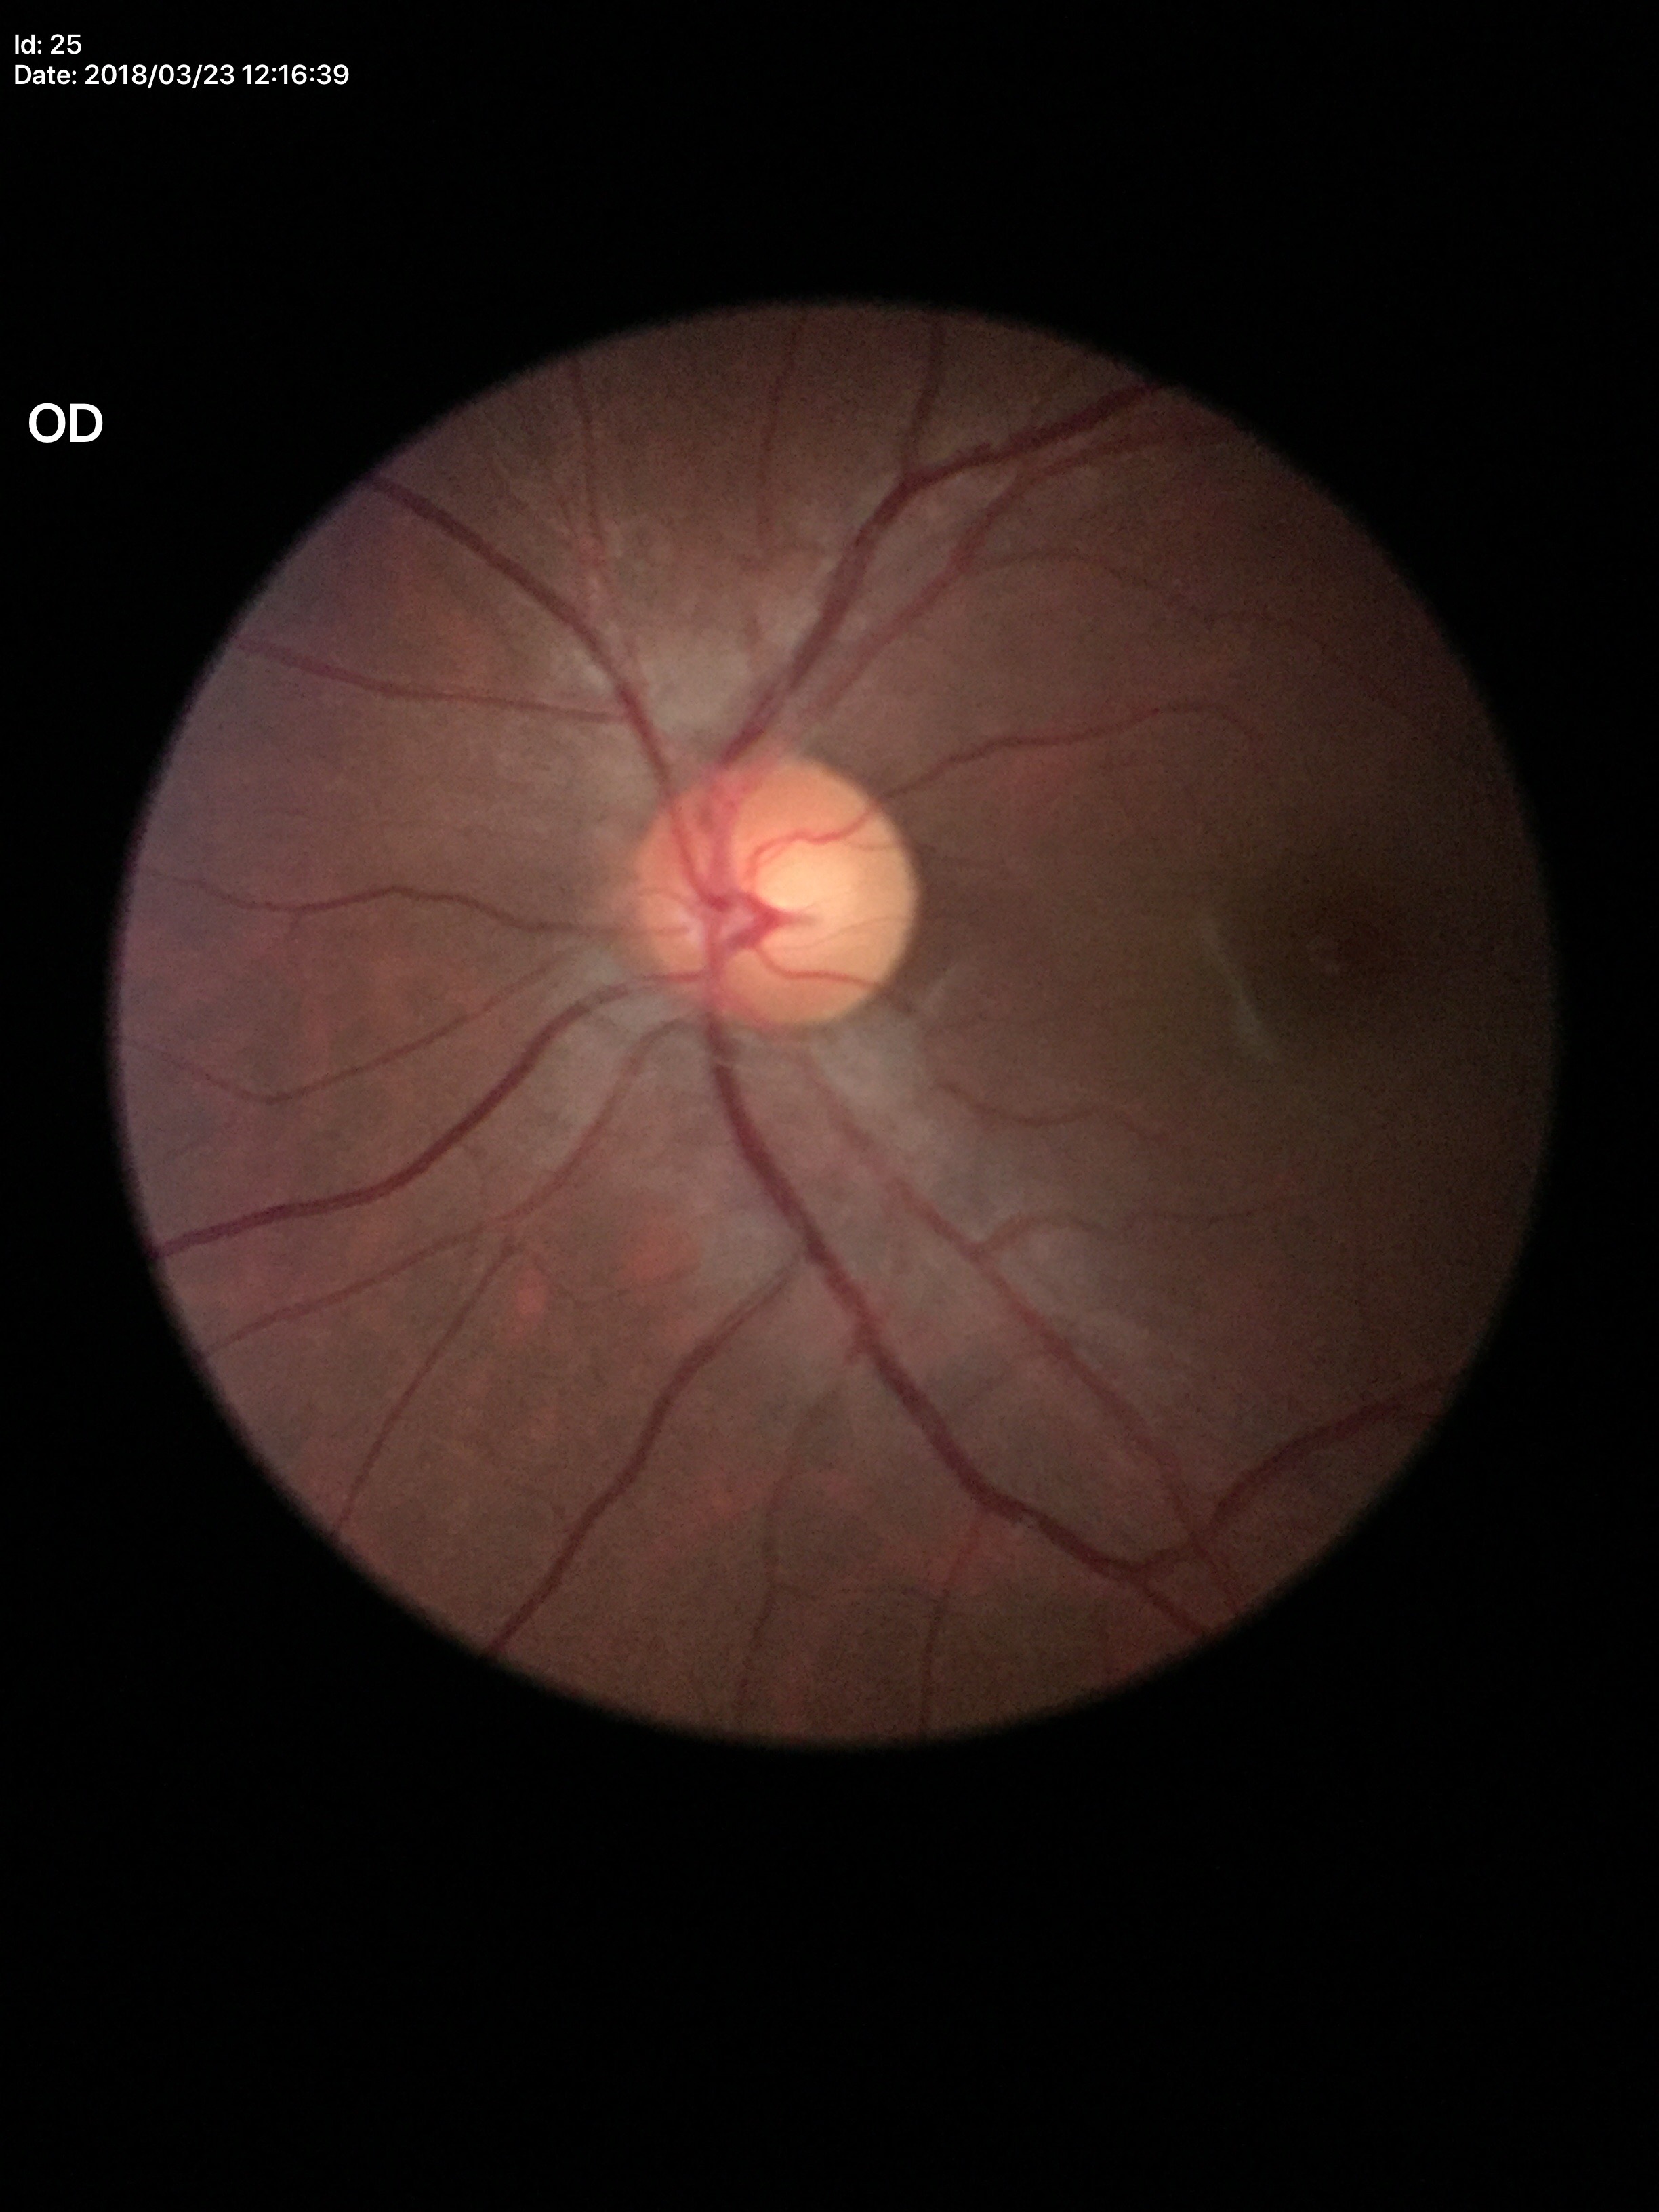

No signs of glaucoma (one of five ophthalmologists flagged glaucoma suspect). Vertical cup-to-disc ratio (VCDR): 0.55. Horizontal cup-to-disc ratio (HCDR): 0.58.